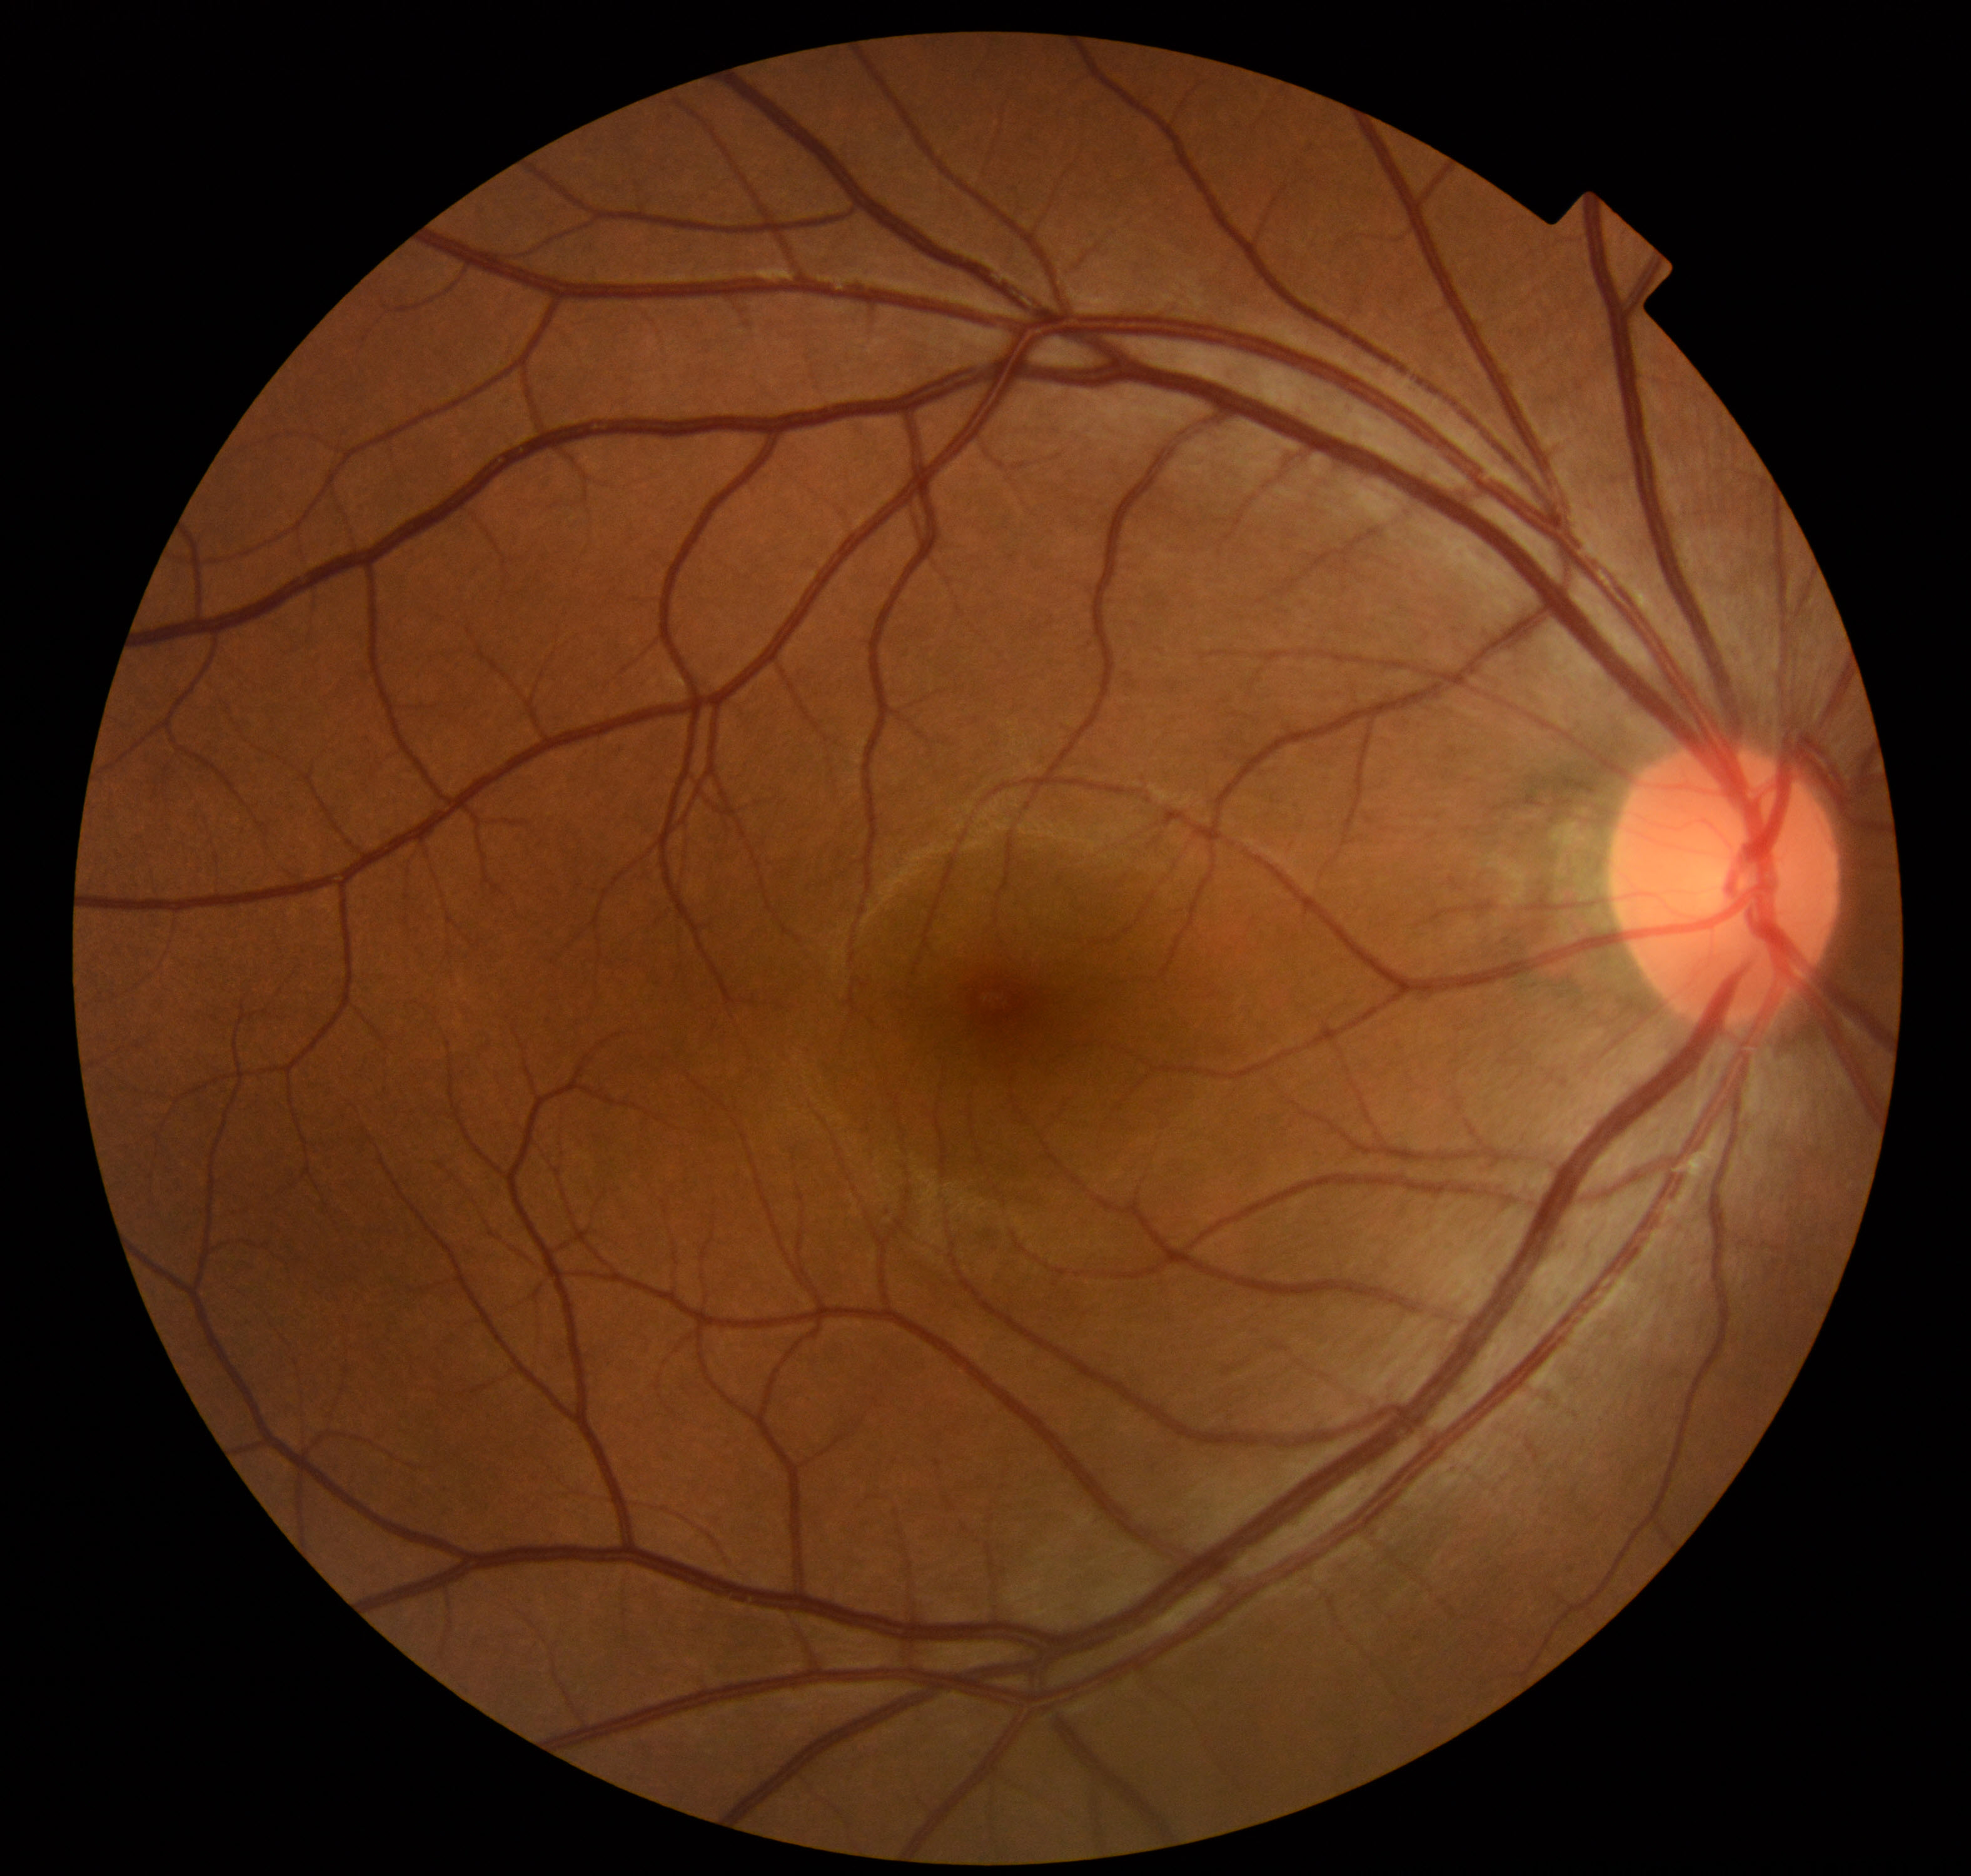
No abnormal findings on fundus examination.